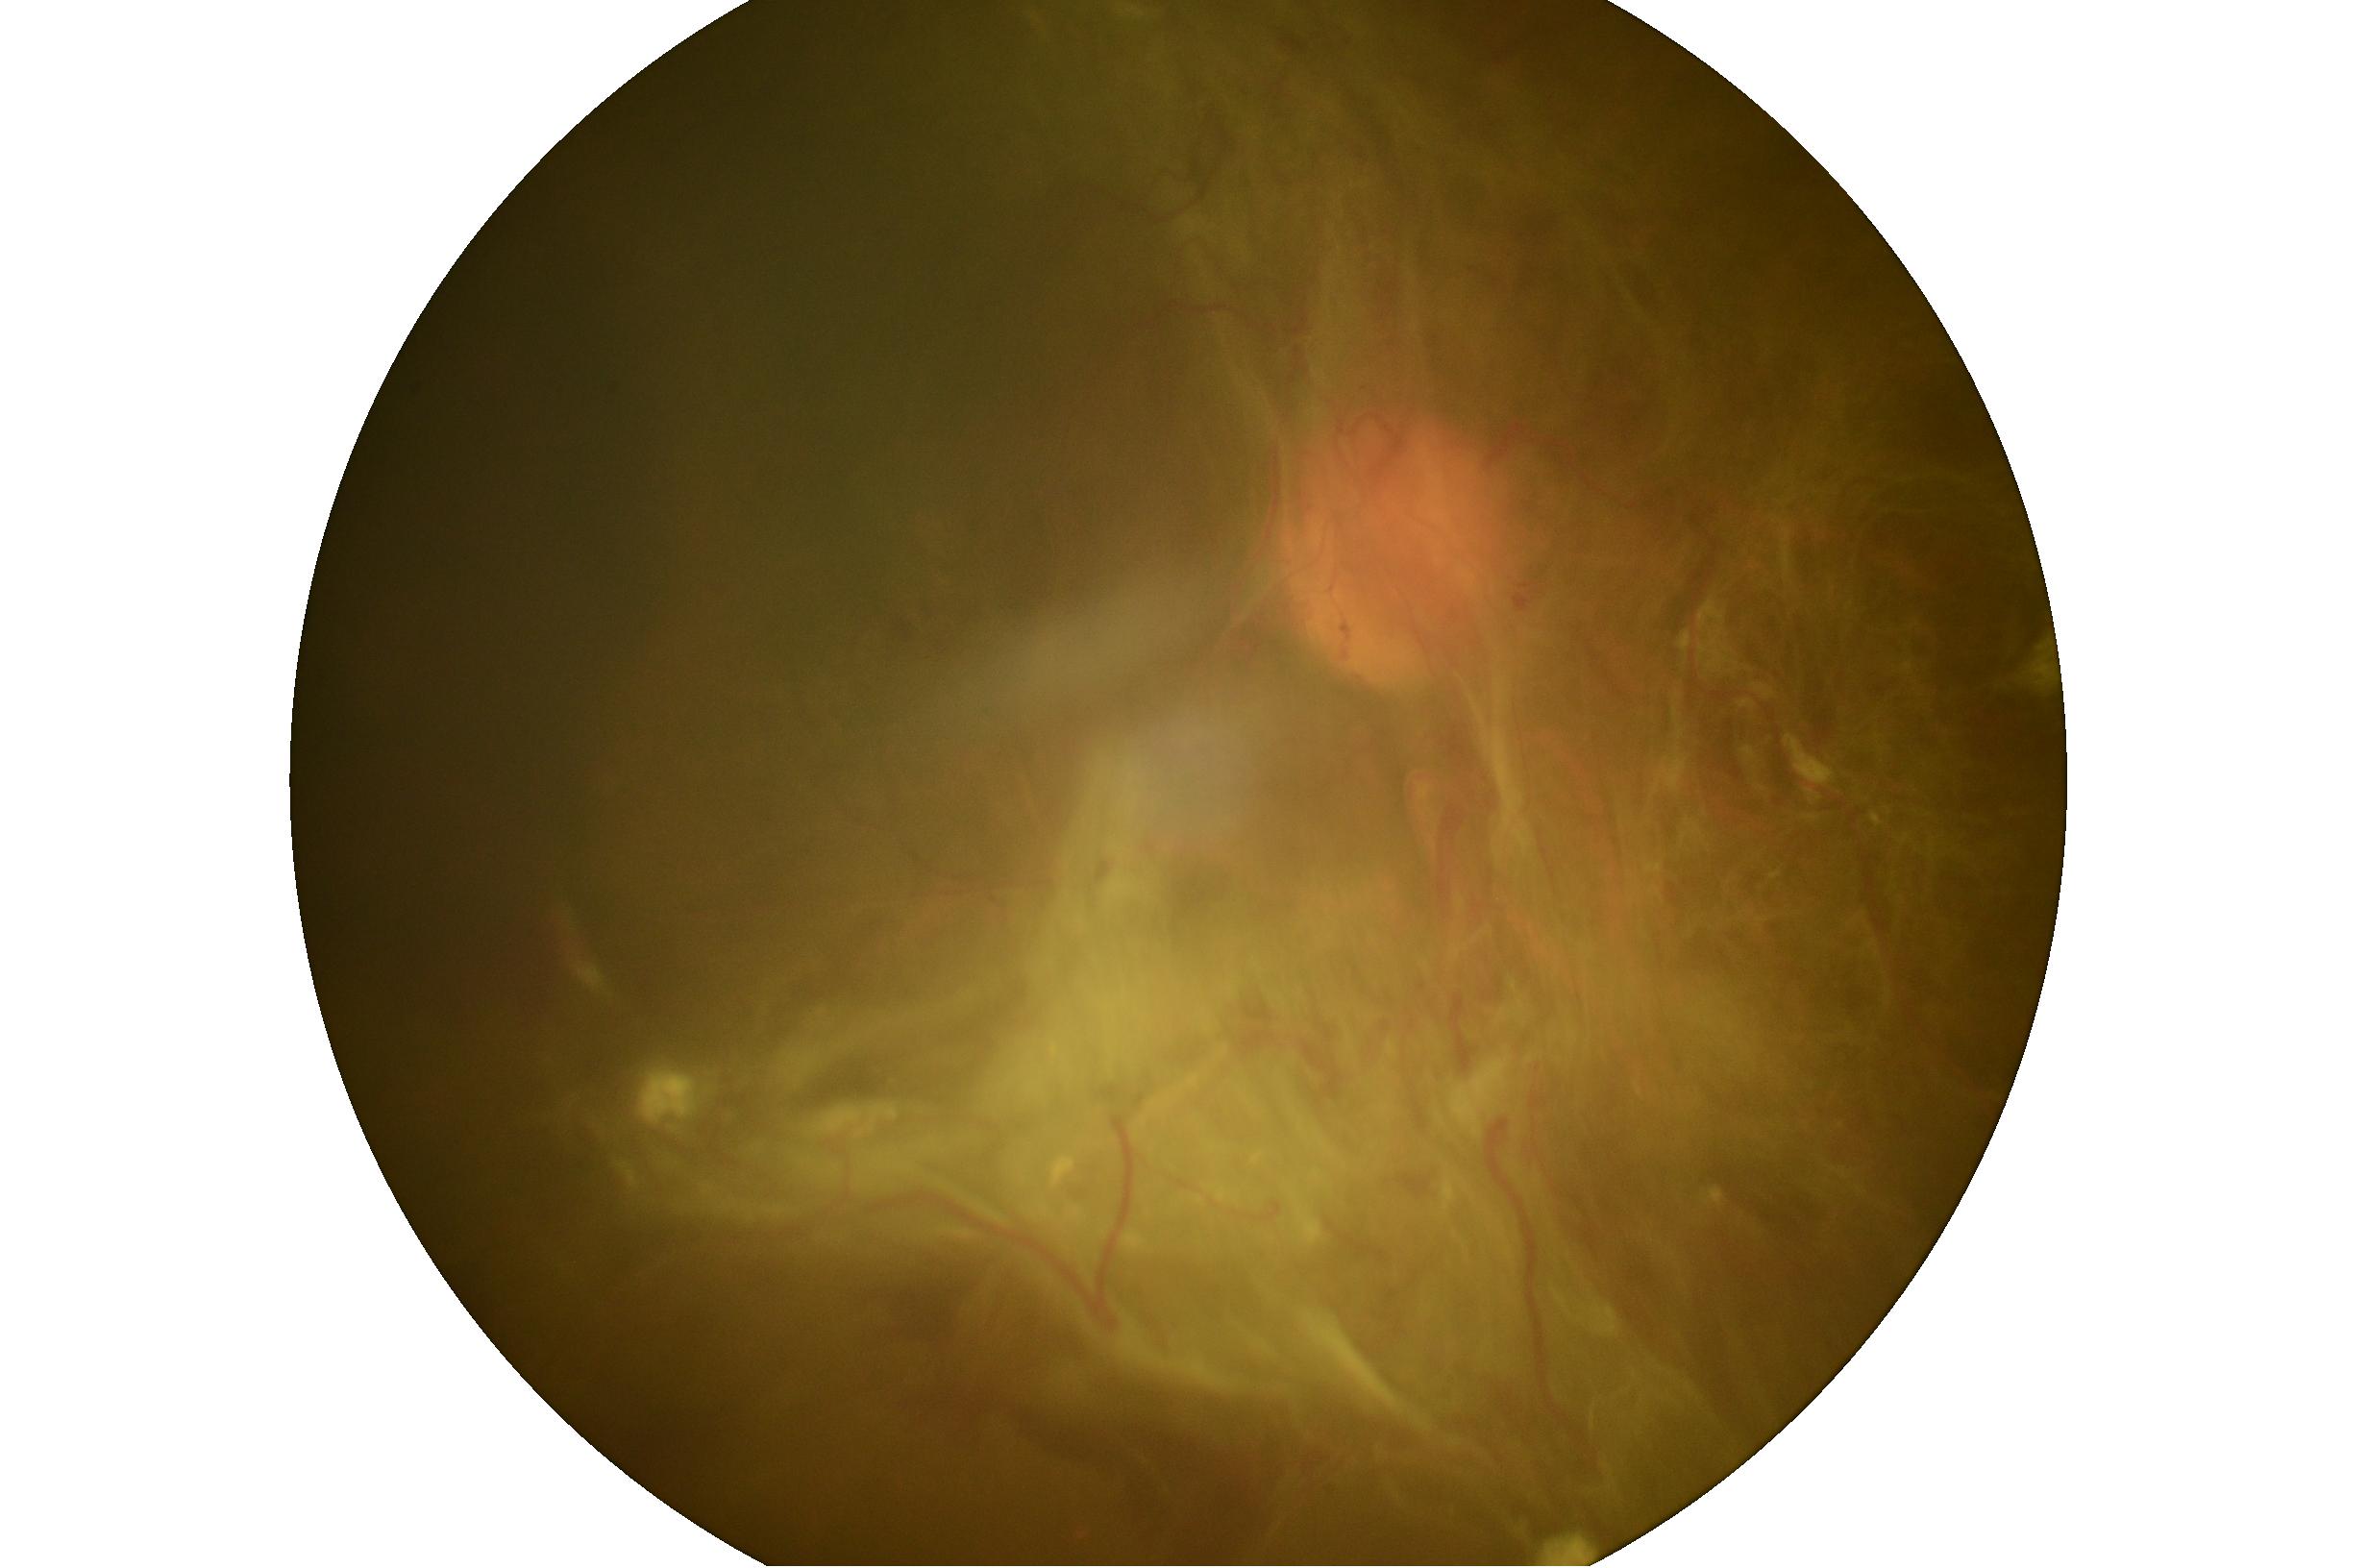
Disease class: proliferative diabetic retinopathy. Retinopathy: PDR (grade 4).